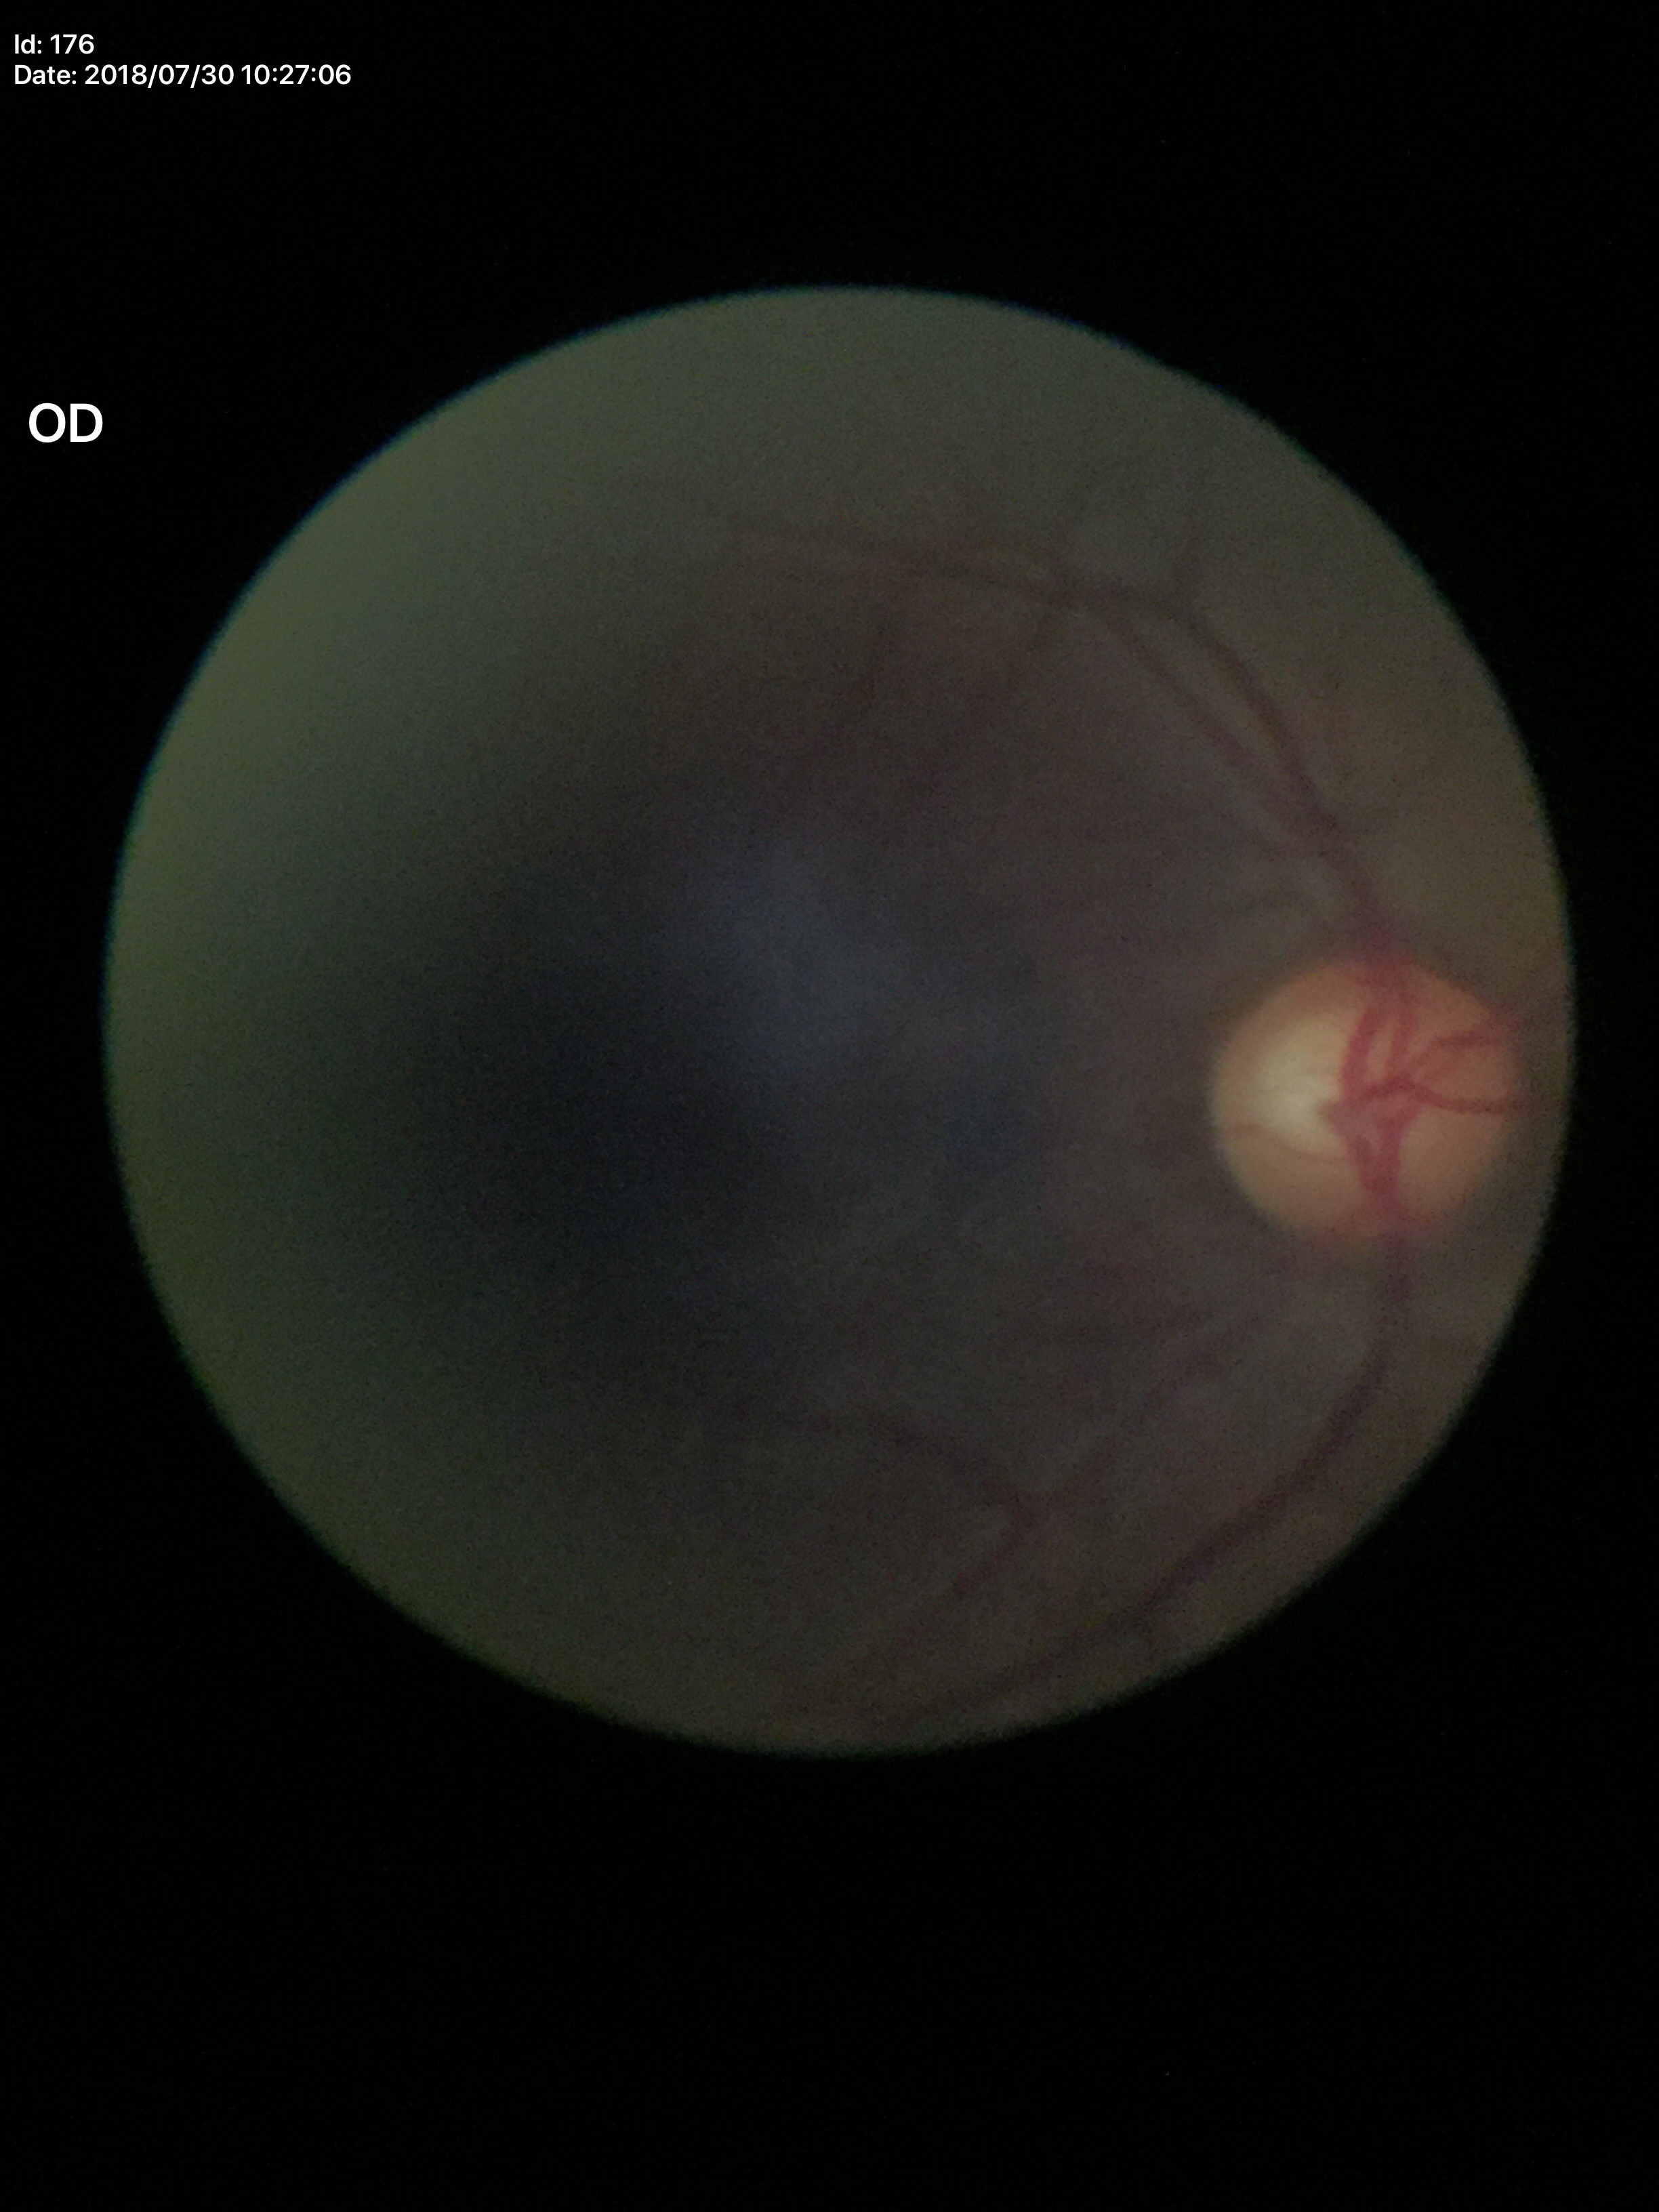

horizontal C/D ratio: 0.61
vertical C/D ratio: 0.59
Glaucoma evaluation: not suspect
area cup-to-disc ratio: 0.36